640x480; wide-field fundus image from infant ROP screening; Clarity RetCam 3, 130° FOV:
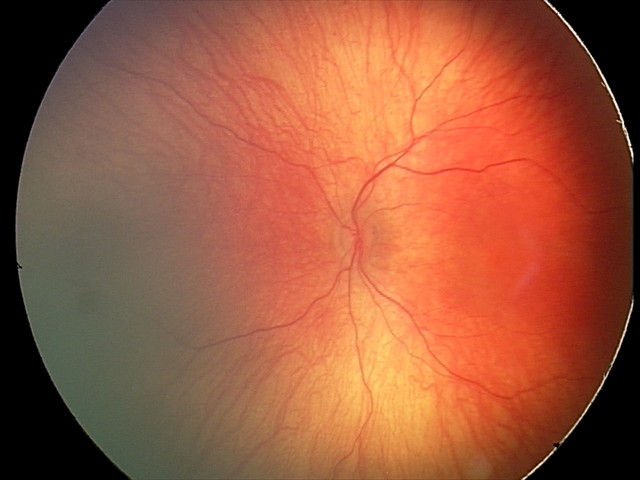
Screening diagnosis: normal fundus examination.